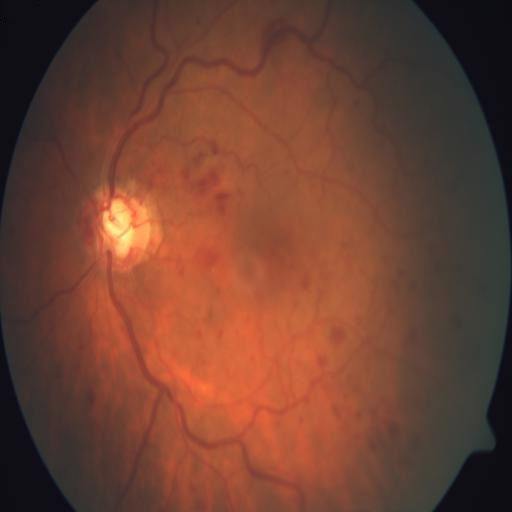 Pathology: central retinal vein occlusion.